Davis DR grading; nonmydriatic
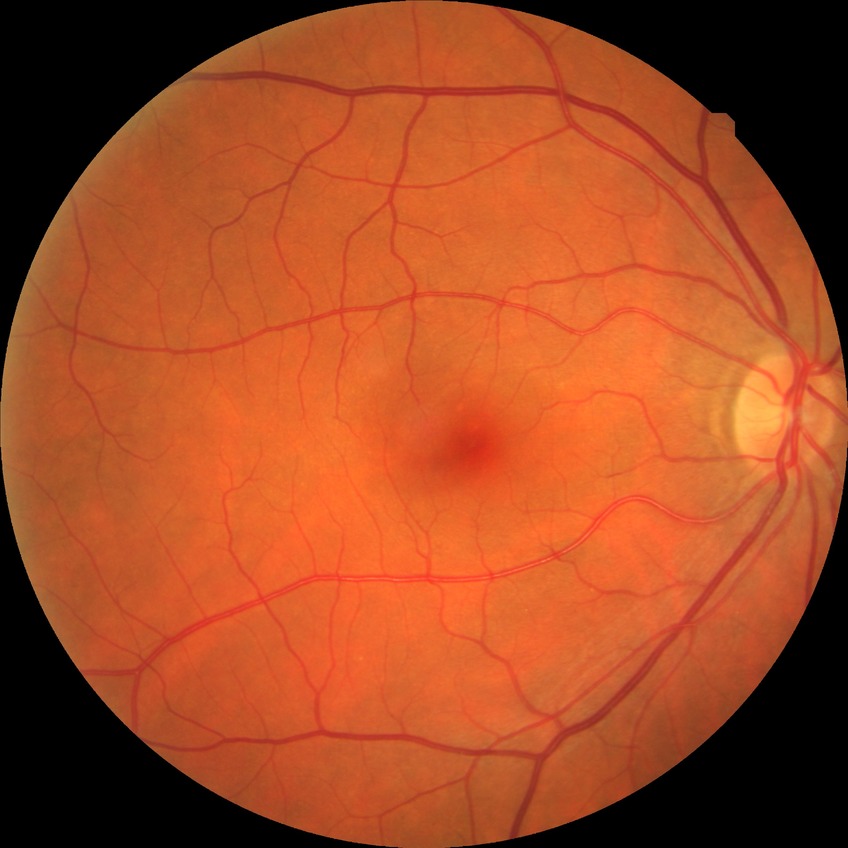

No DR findings.
DR severity is NDR.